45-degree field of view, retinal fundus photograph, 2184 by 1690 pixels.
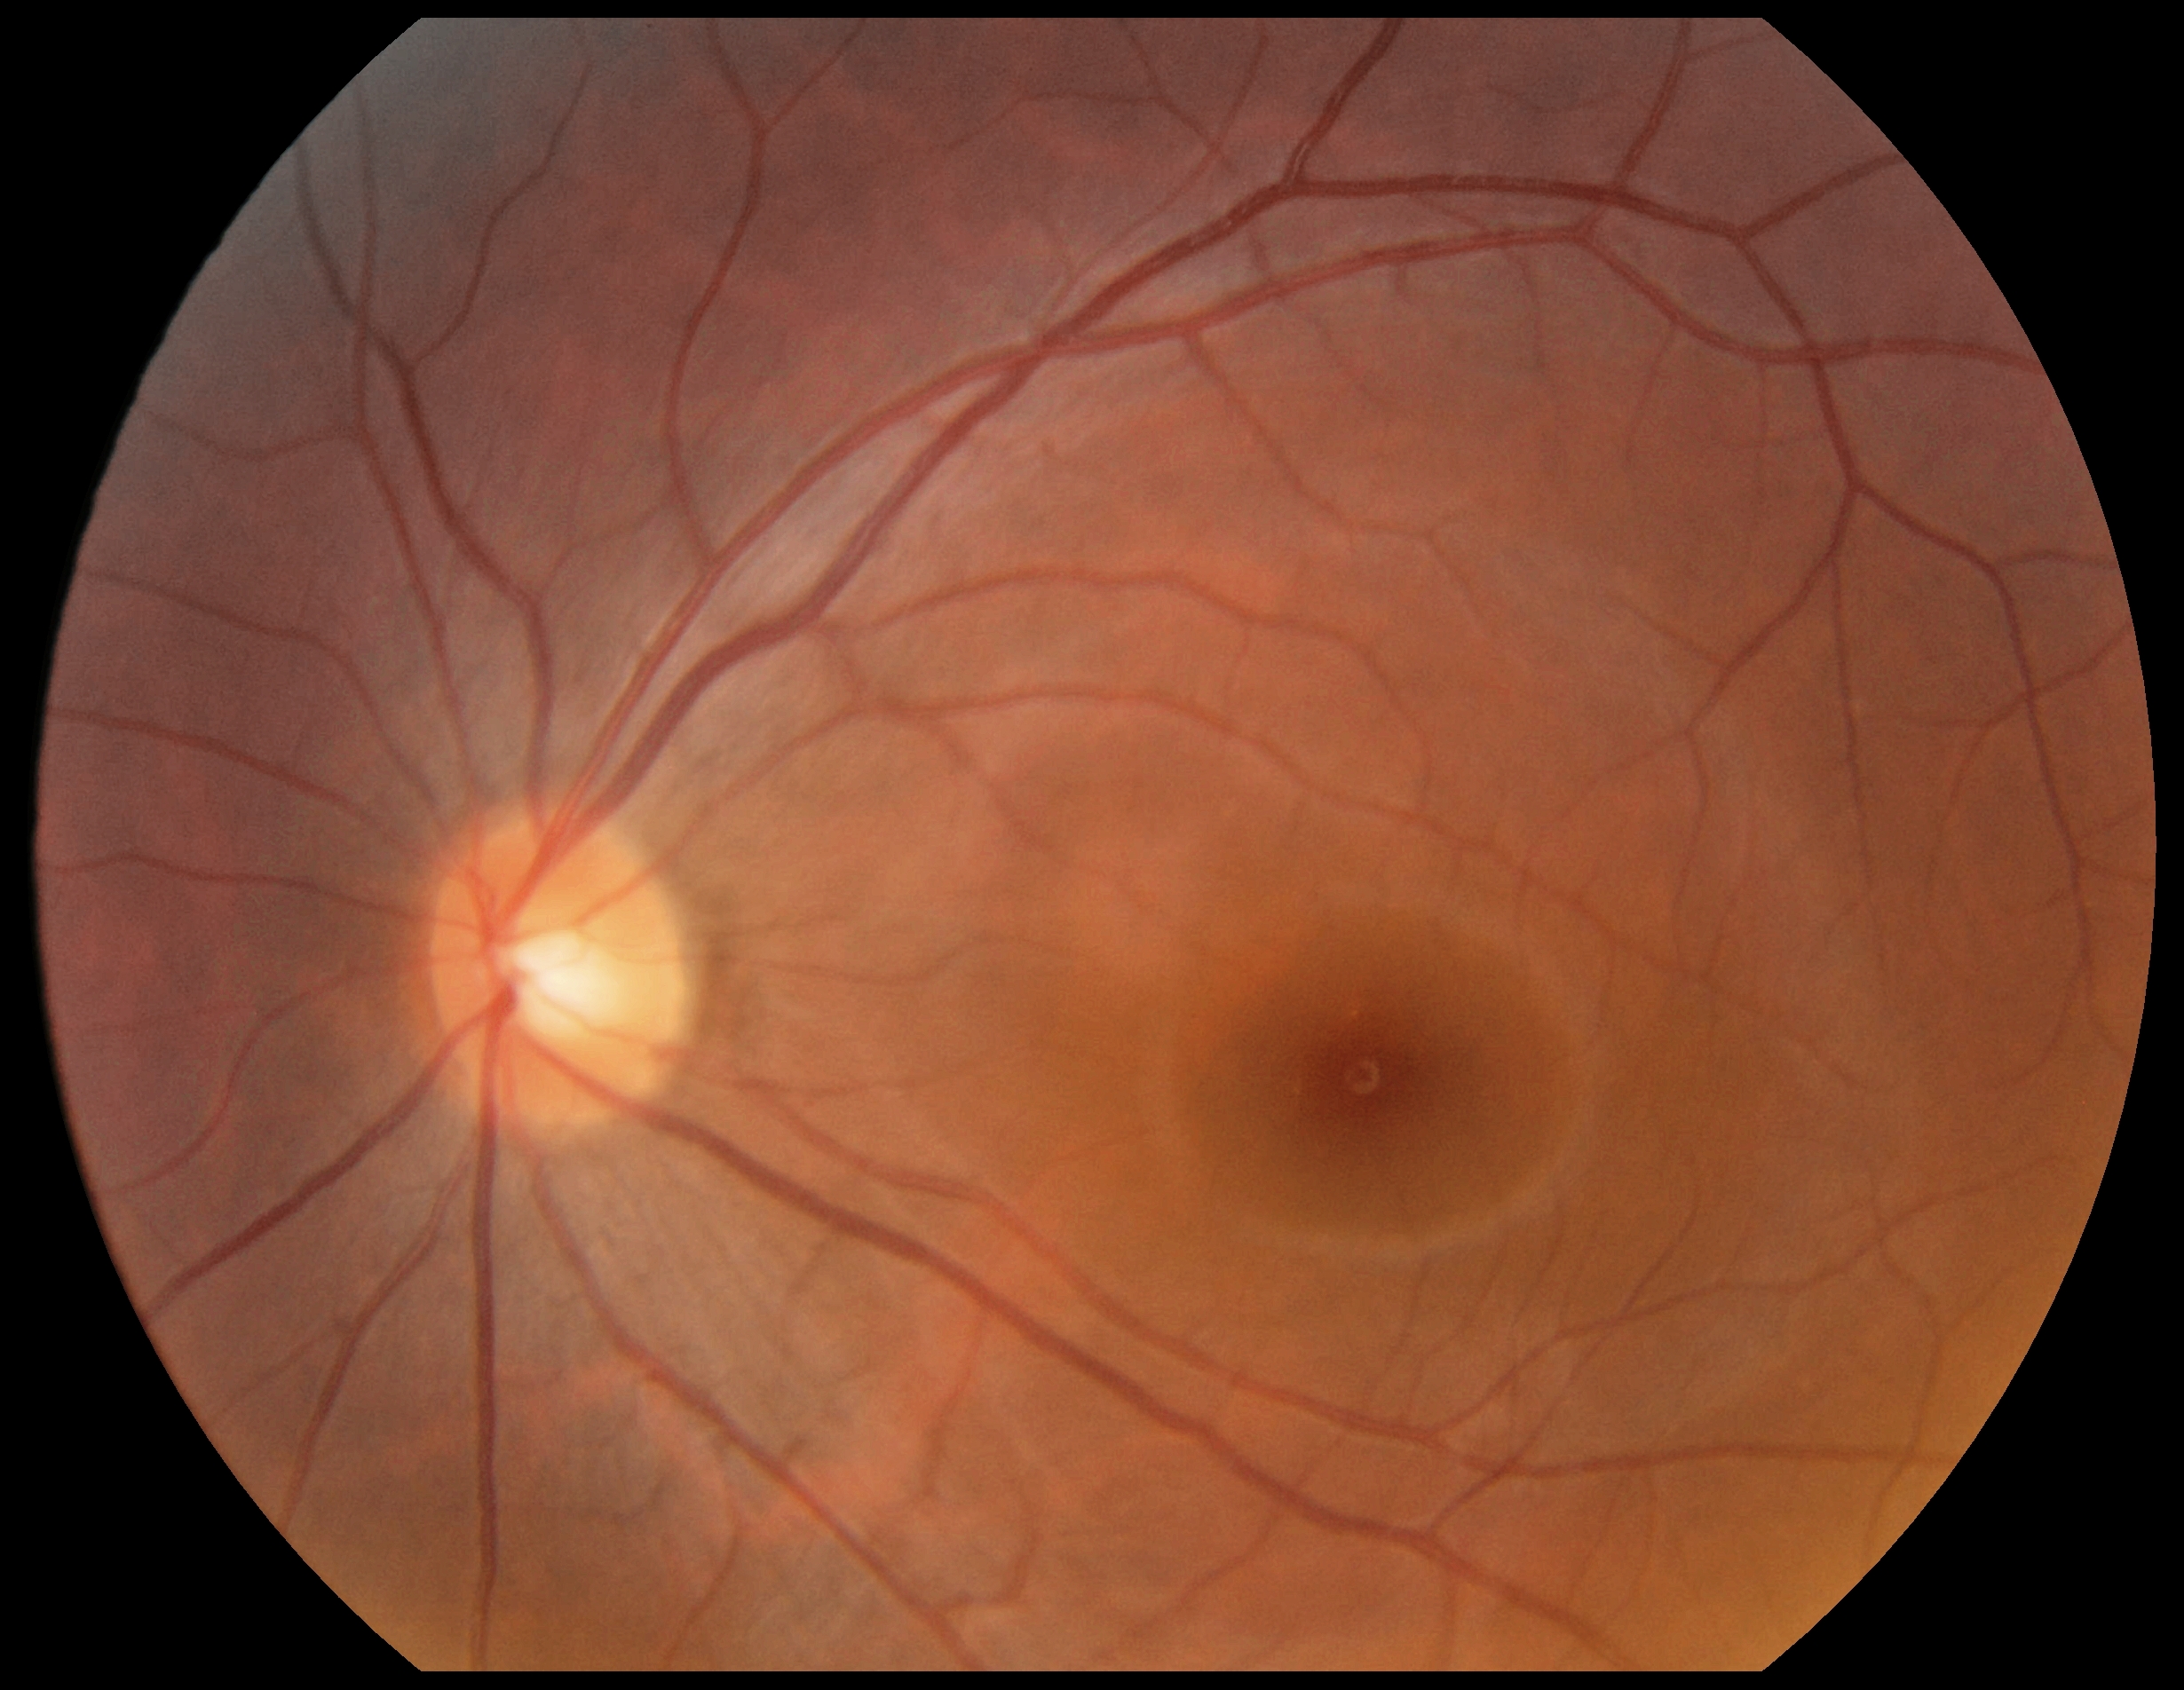
diabetic retinopathy severity: no apparent retinopathy (grade 0) — no visible signs of diabetic retinopathy.